Modified Davis classification, color fundus image:
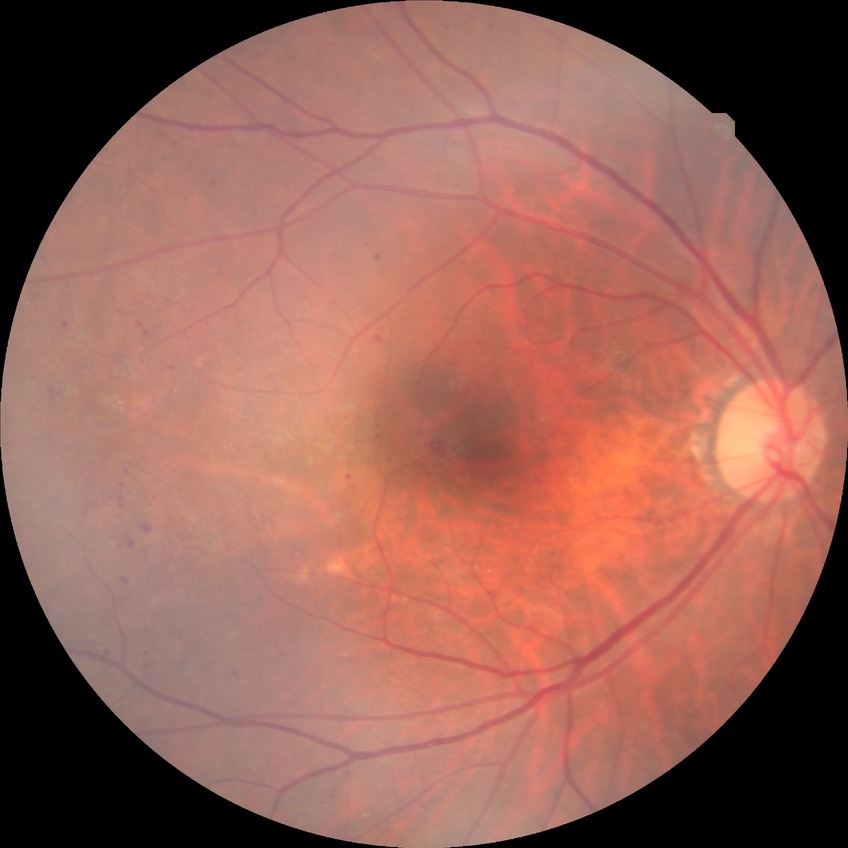
DR class: non-proliferative diabetic retinopathy, DR: PPDR.